Nonmydriatic · fundus photo · 848 by 848 pixels: 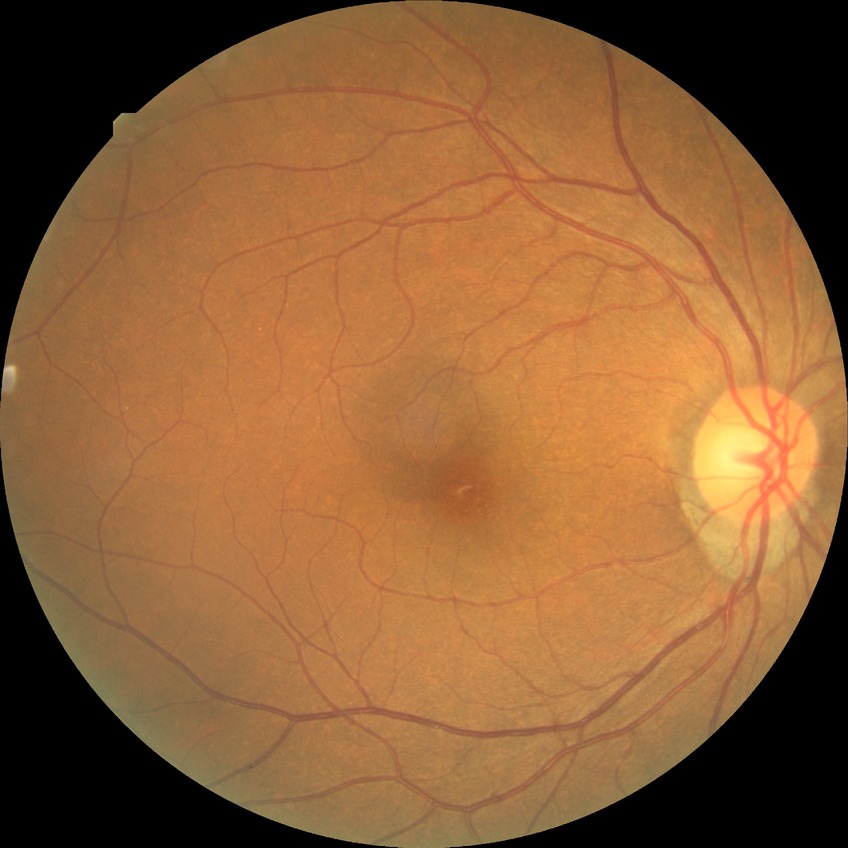

diabetic retinopathy (DR) = no diabetic retinopathy (NDR).